Infant wide-field retinal image
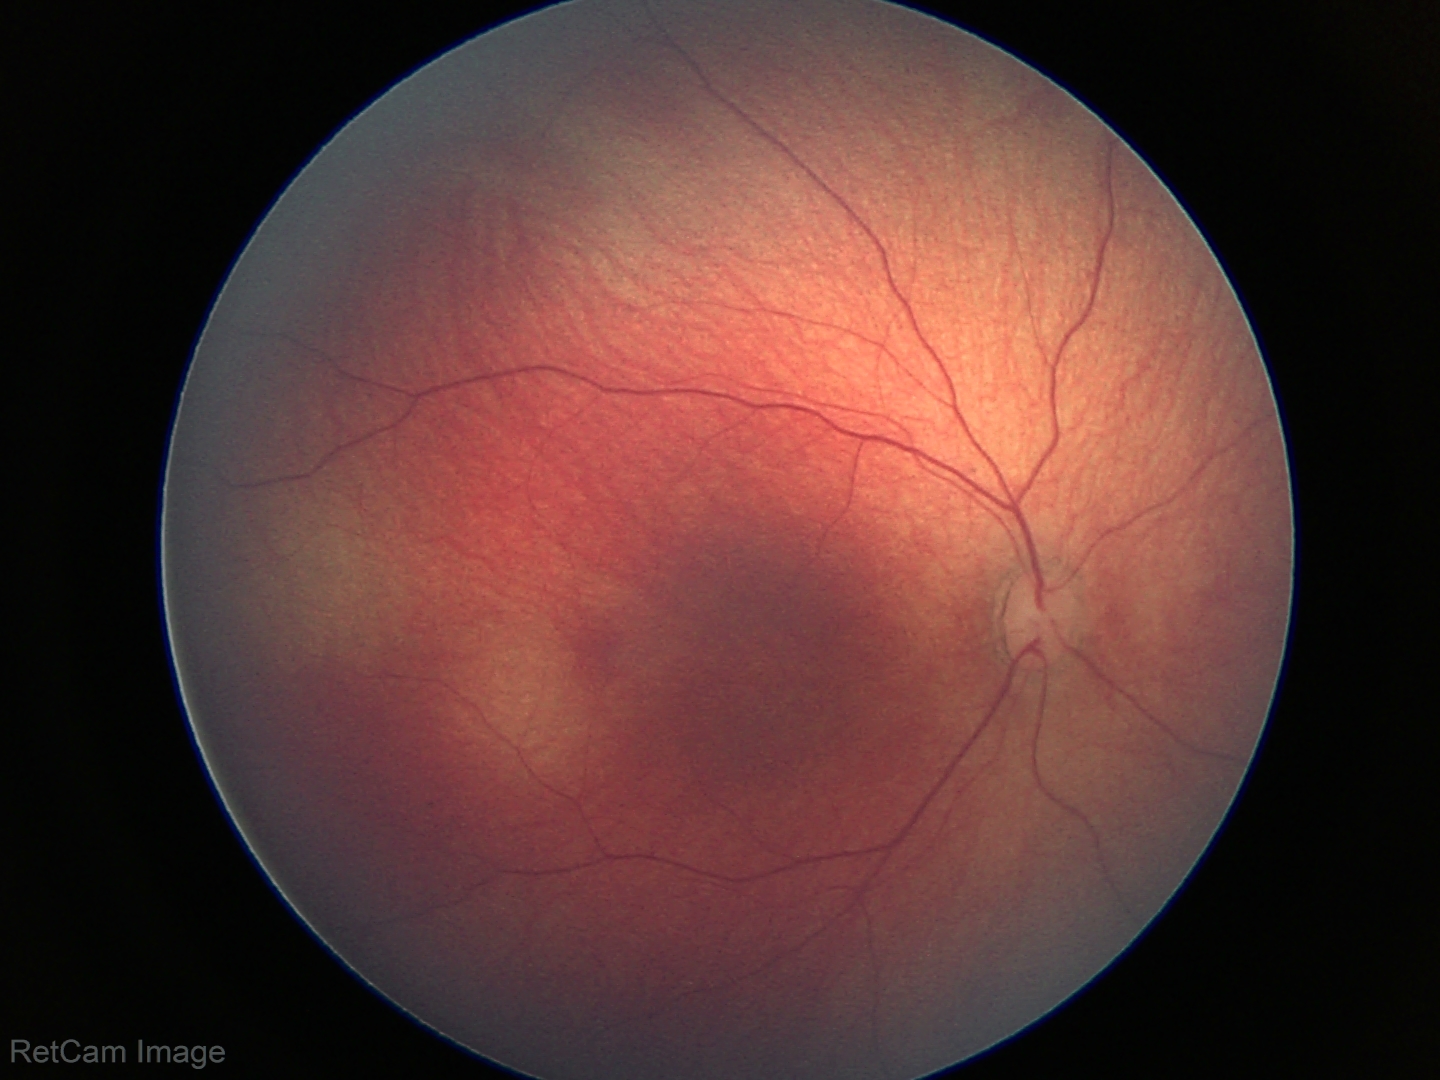
Normal screening examination.